Camera: Topcon TRC-NW8:
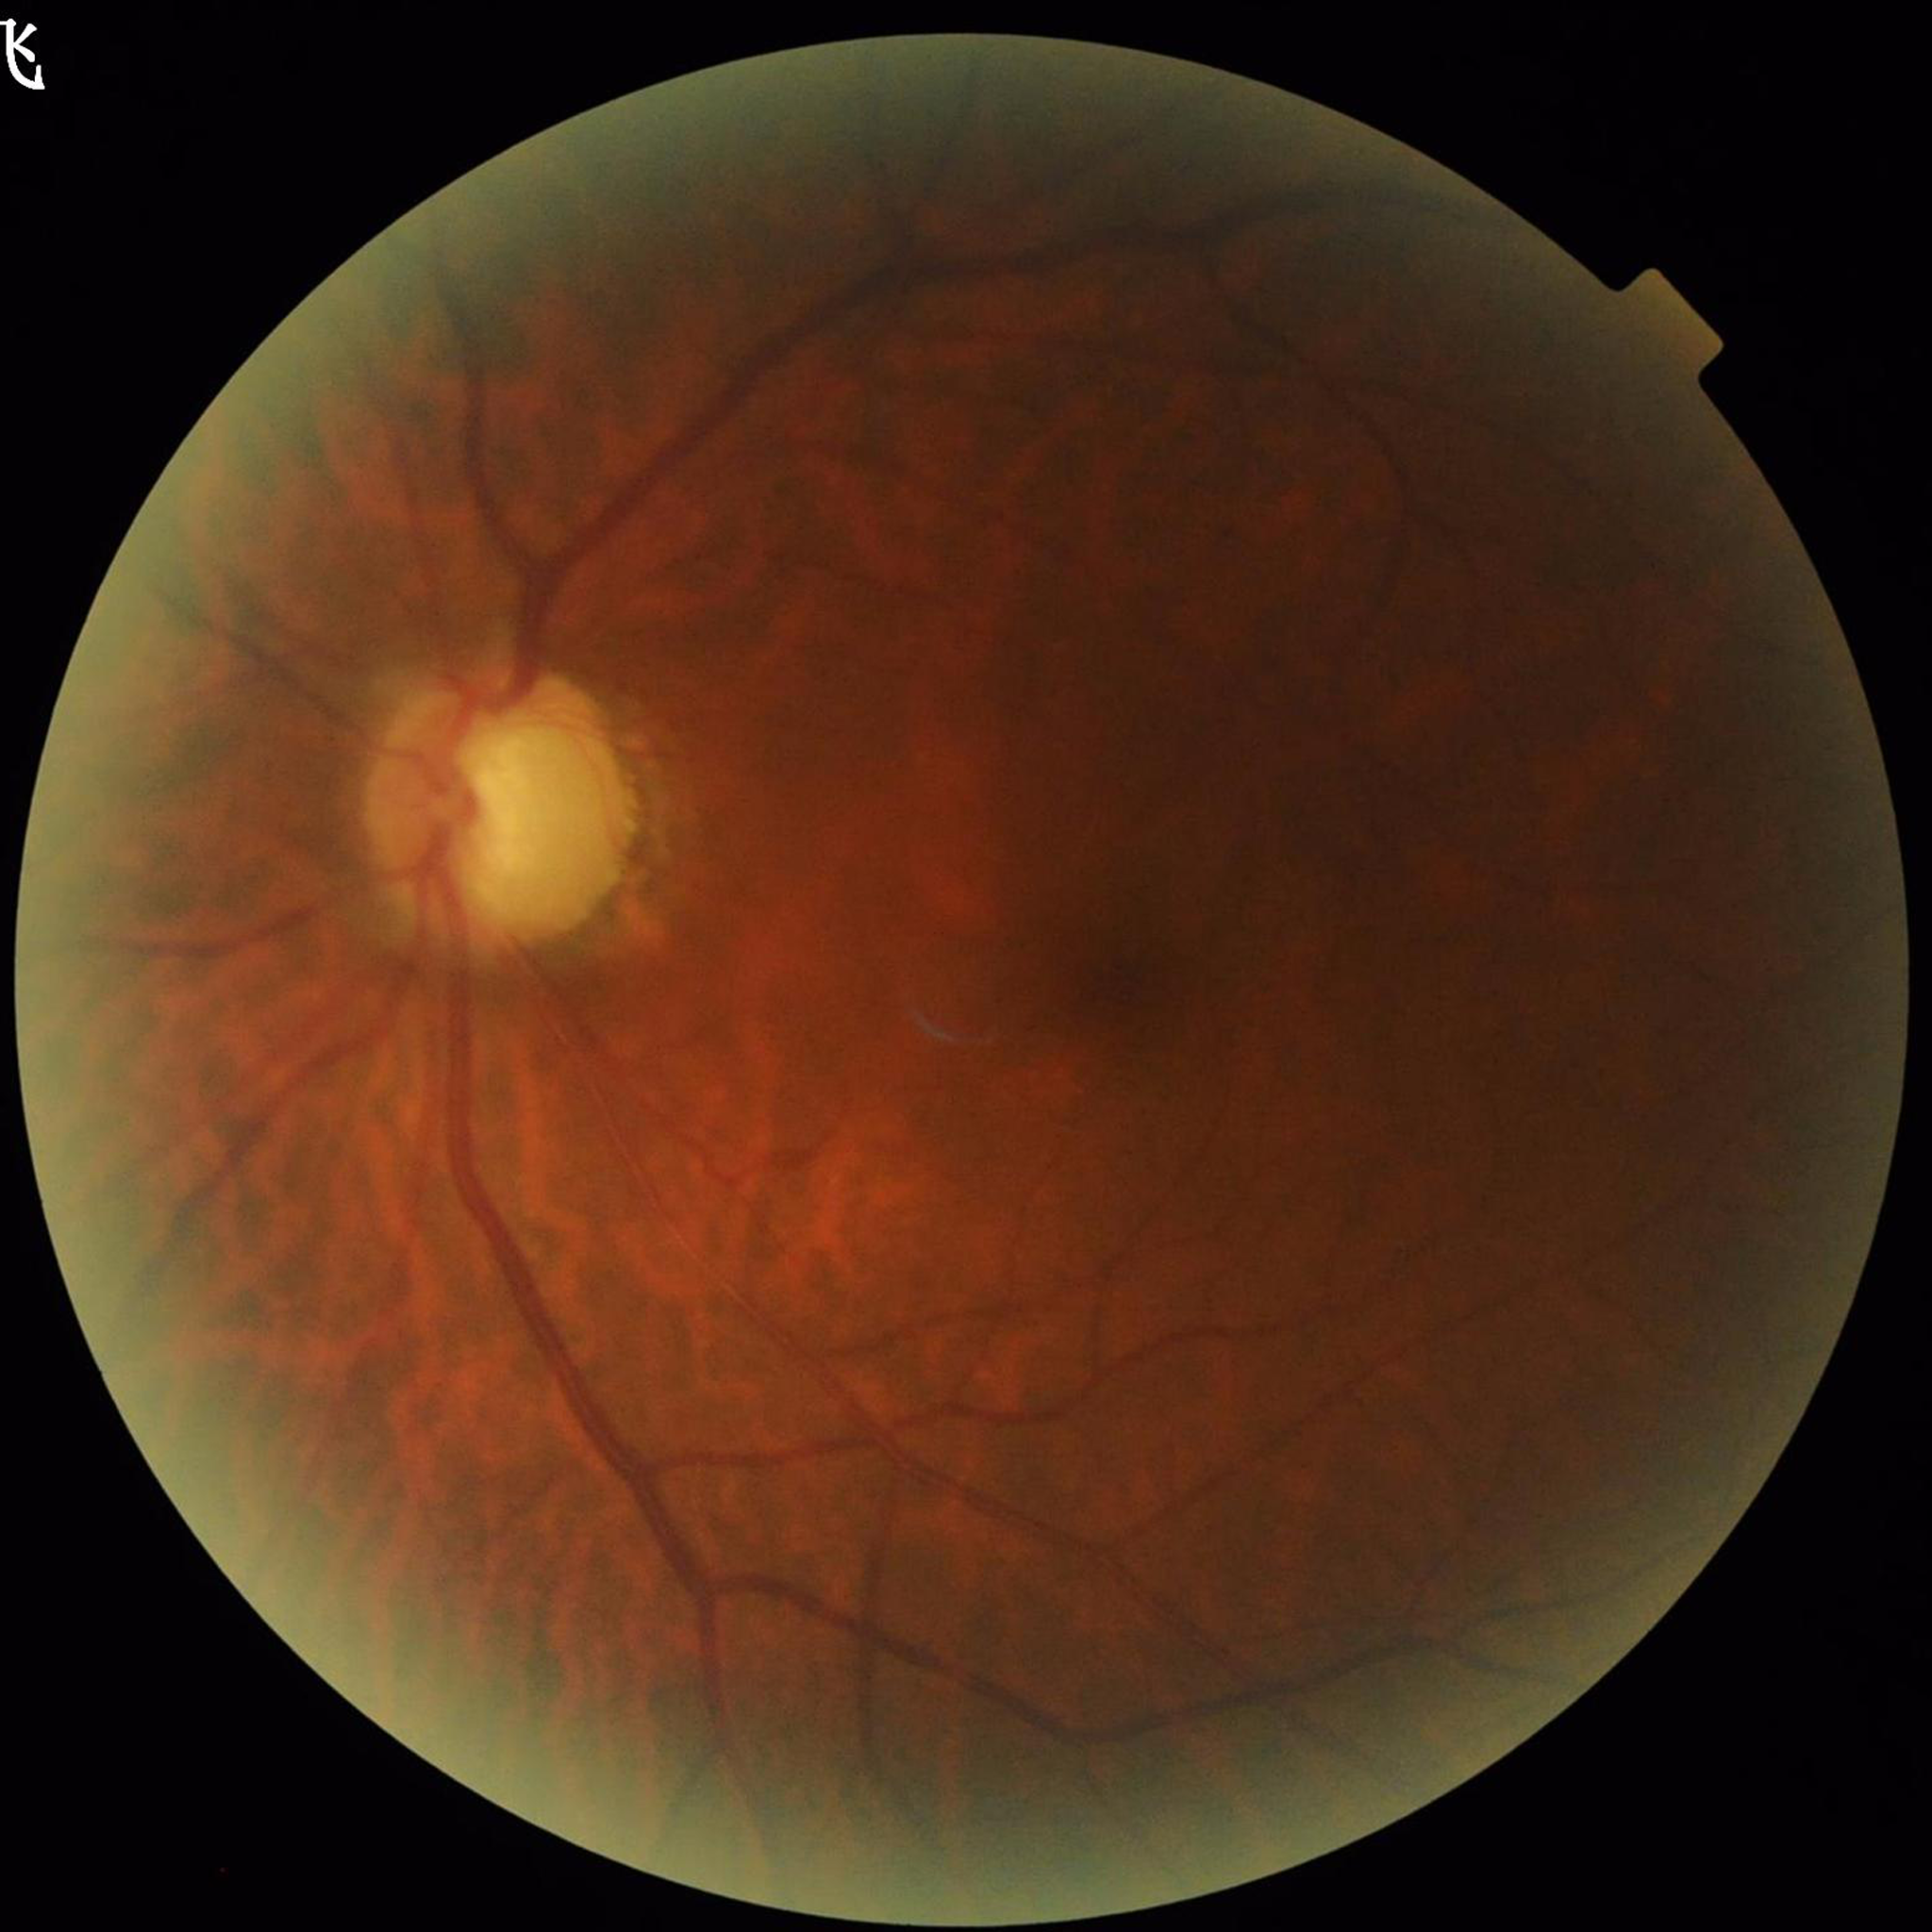 Clinical diagnosis: glaucoma
Quality: blur present, contrast adequate, illumination/color distortion present